45° FOV: 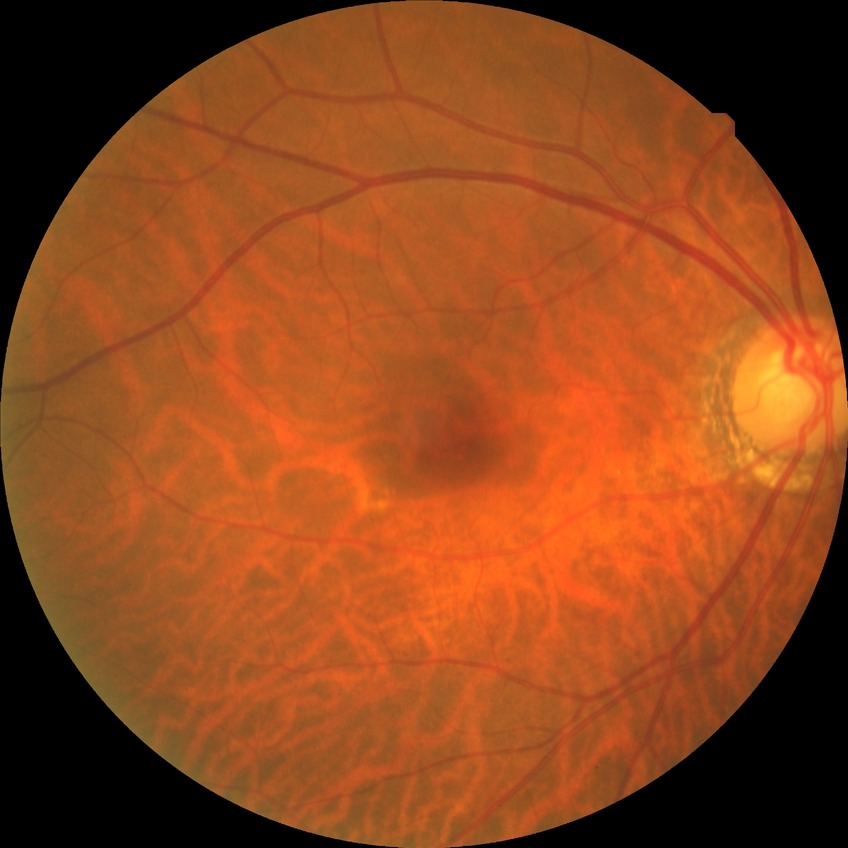

Modified Davis classification is no diabetic retinopathy.